Davis DR grading: 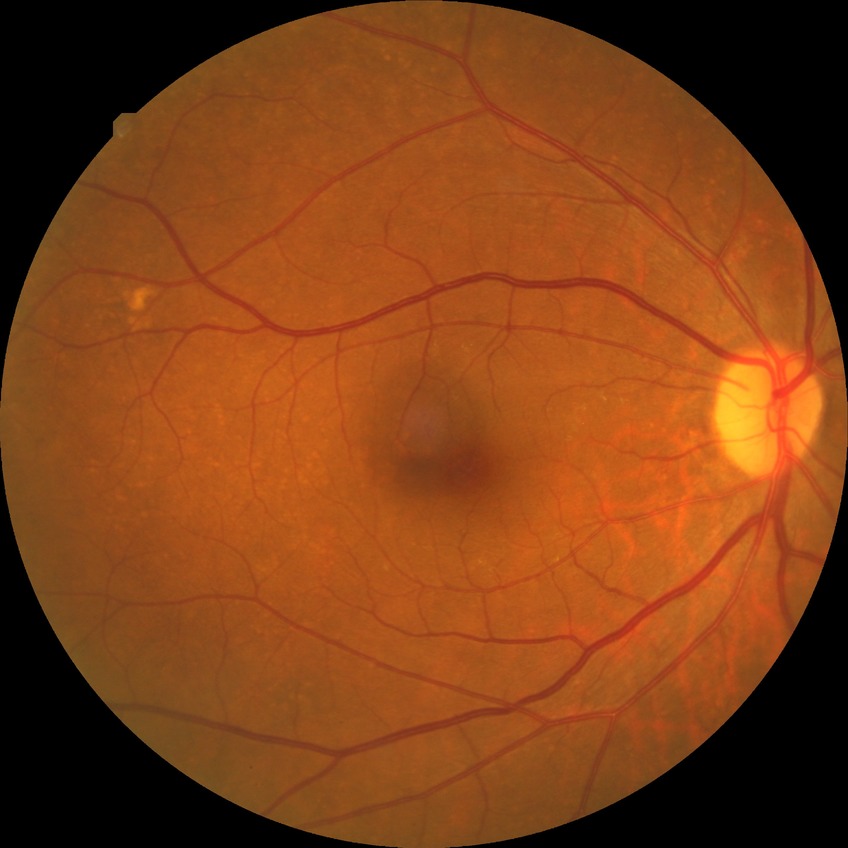

Davis grade: NDR.